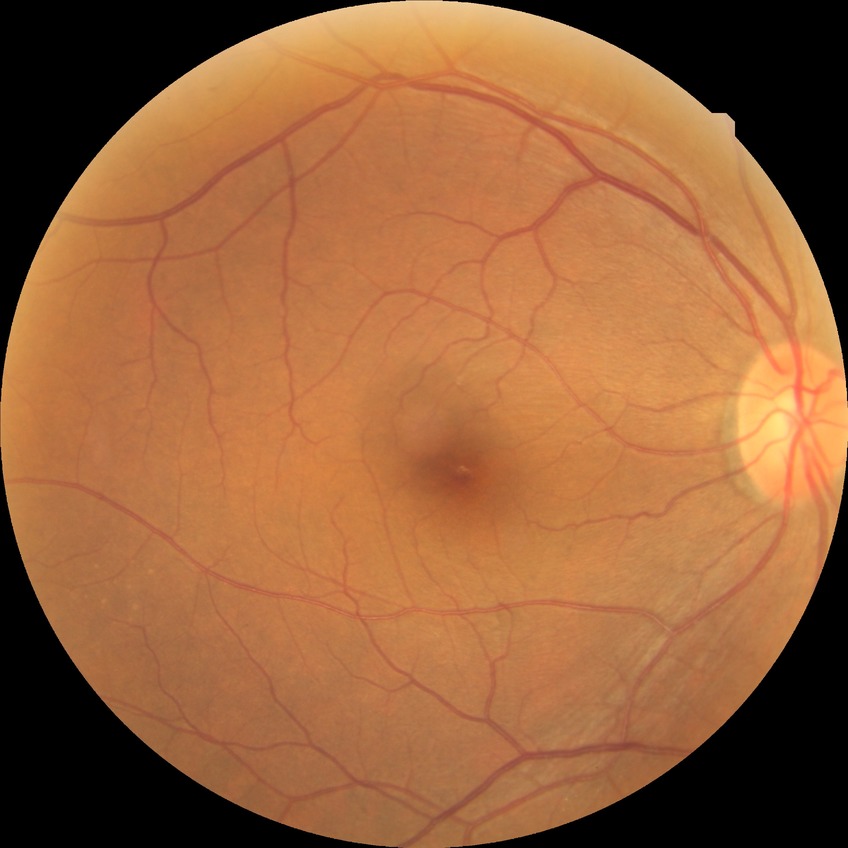 diabetic retinopathy (DR) = no diabetic retinopathy (NDR).